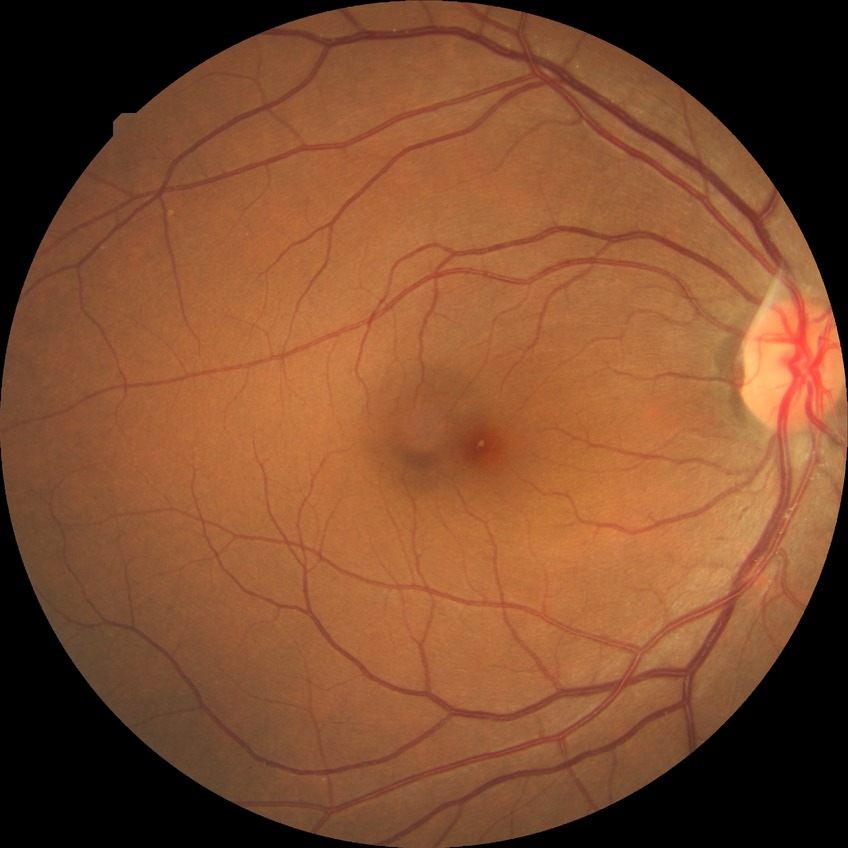 Modified Davis grading: no diabetic retinopathy.